Without pupil dilation. Diabetic retinopathy graded by the modified Davis classification. NIDEK AFC-230 fundus camera. CFP. Image size 848x848. 45° field of view:
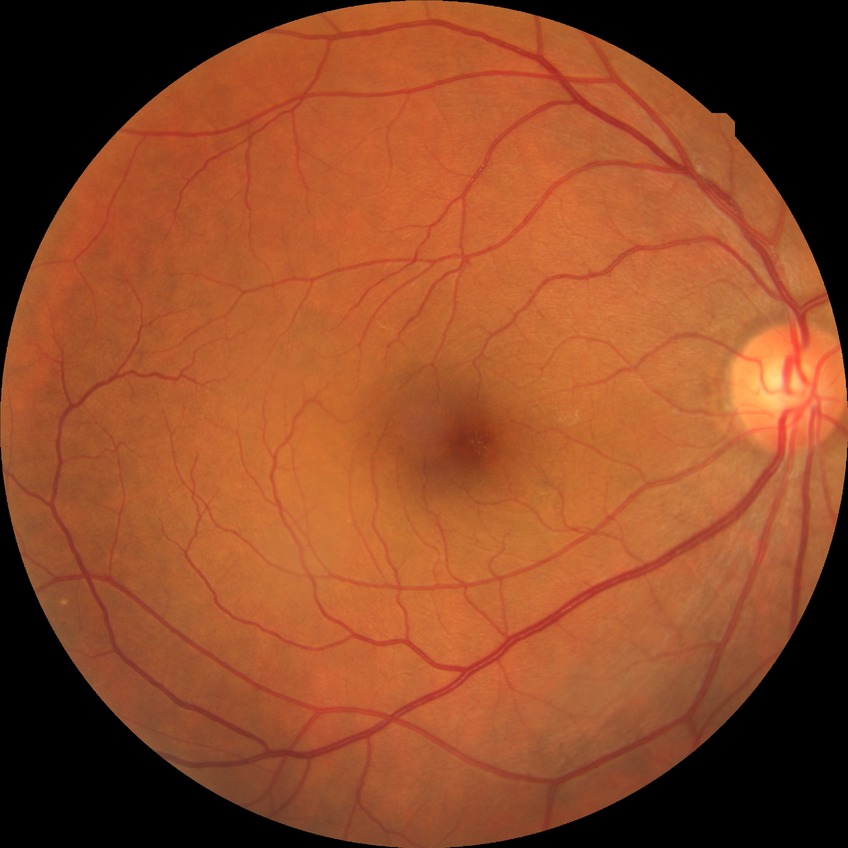
Diabetic retinopathy (DR) is NDR (no diabetic retinopathy).